Wide-field fundus photograph of an infant
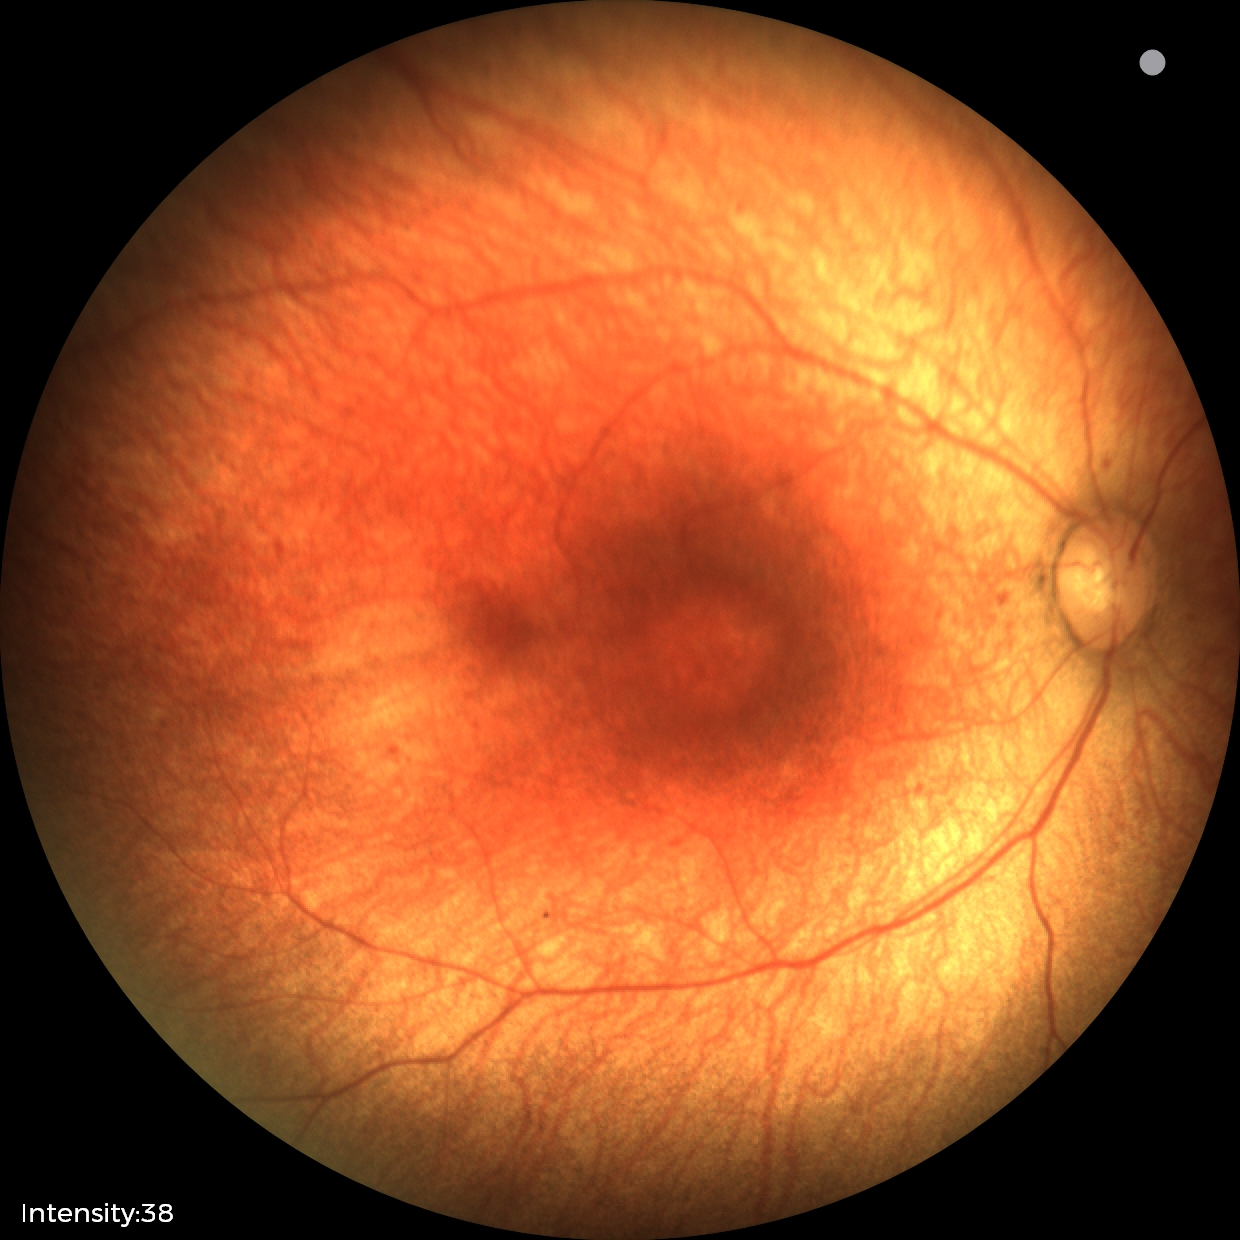

Normal screening examination.